1932x1910, color fundus image.
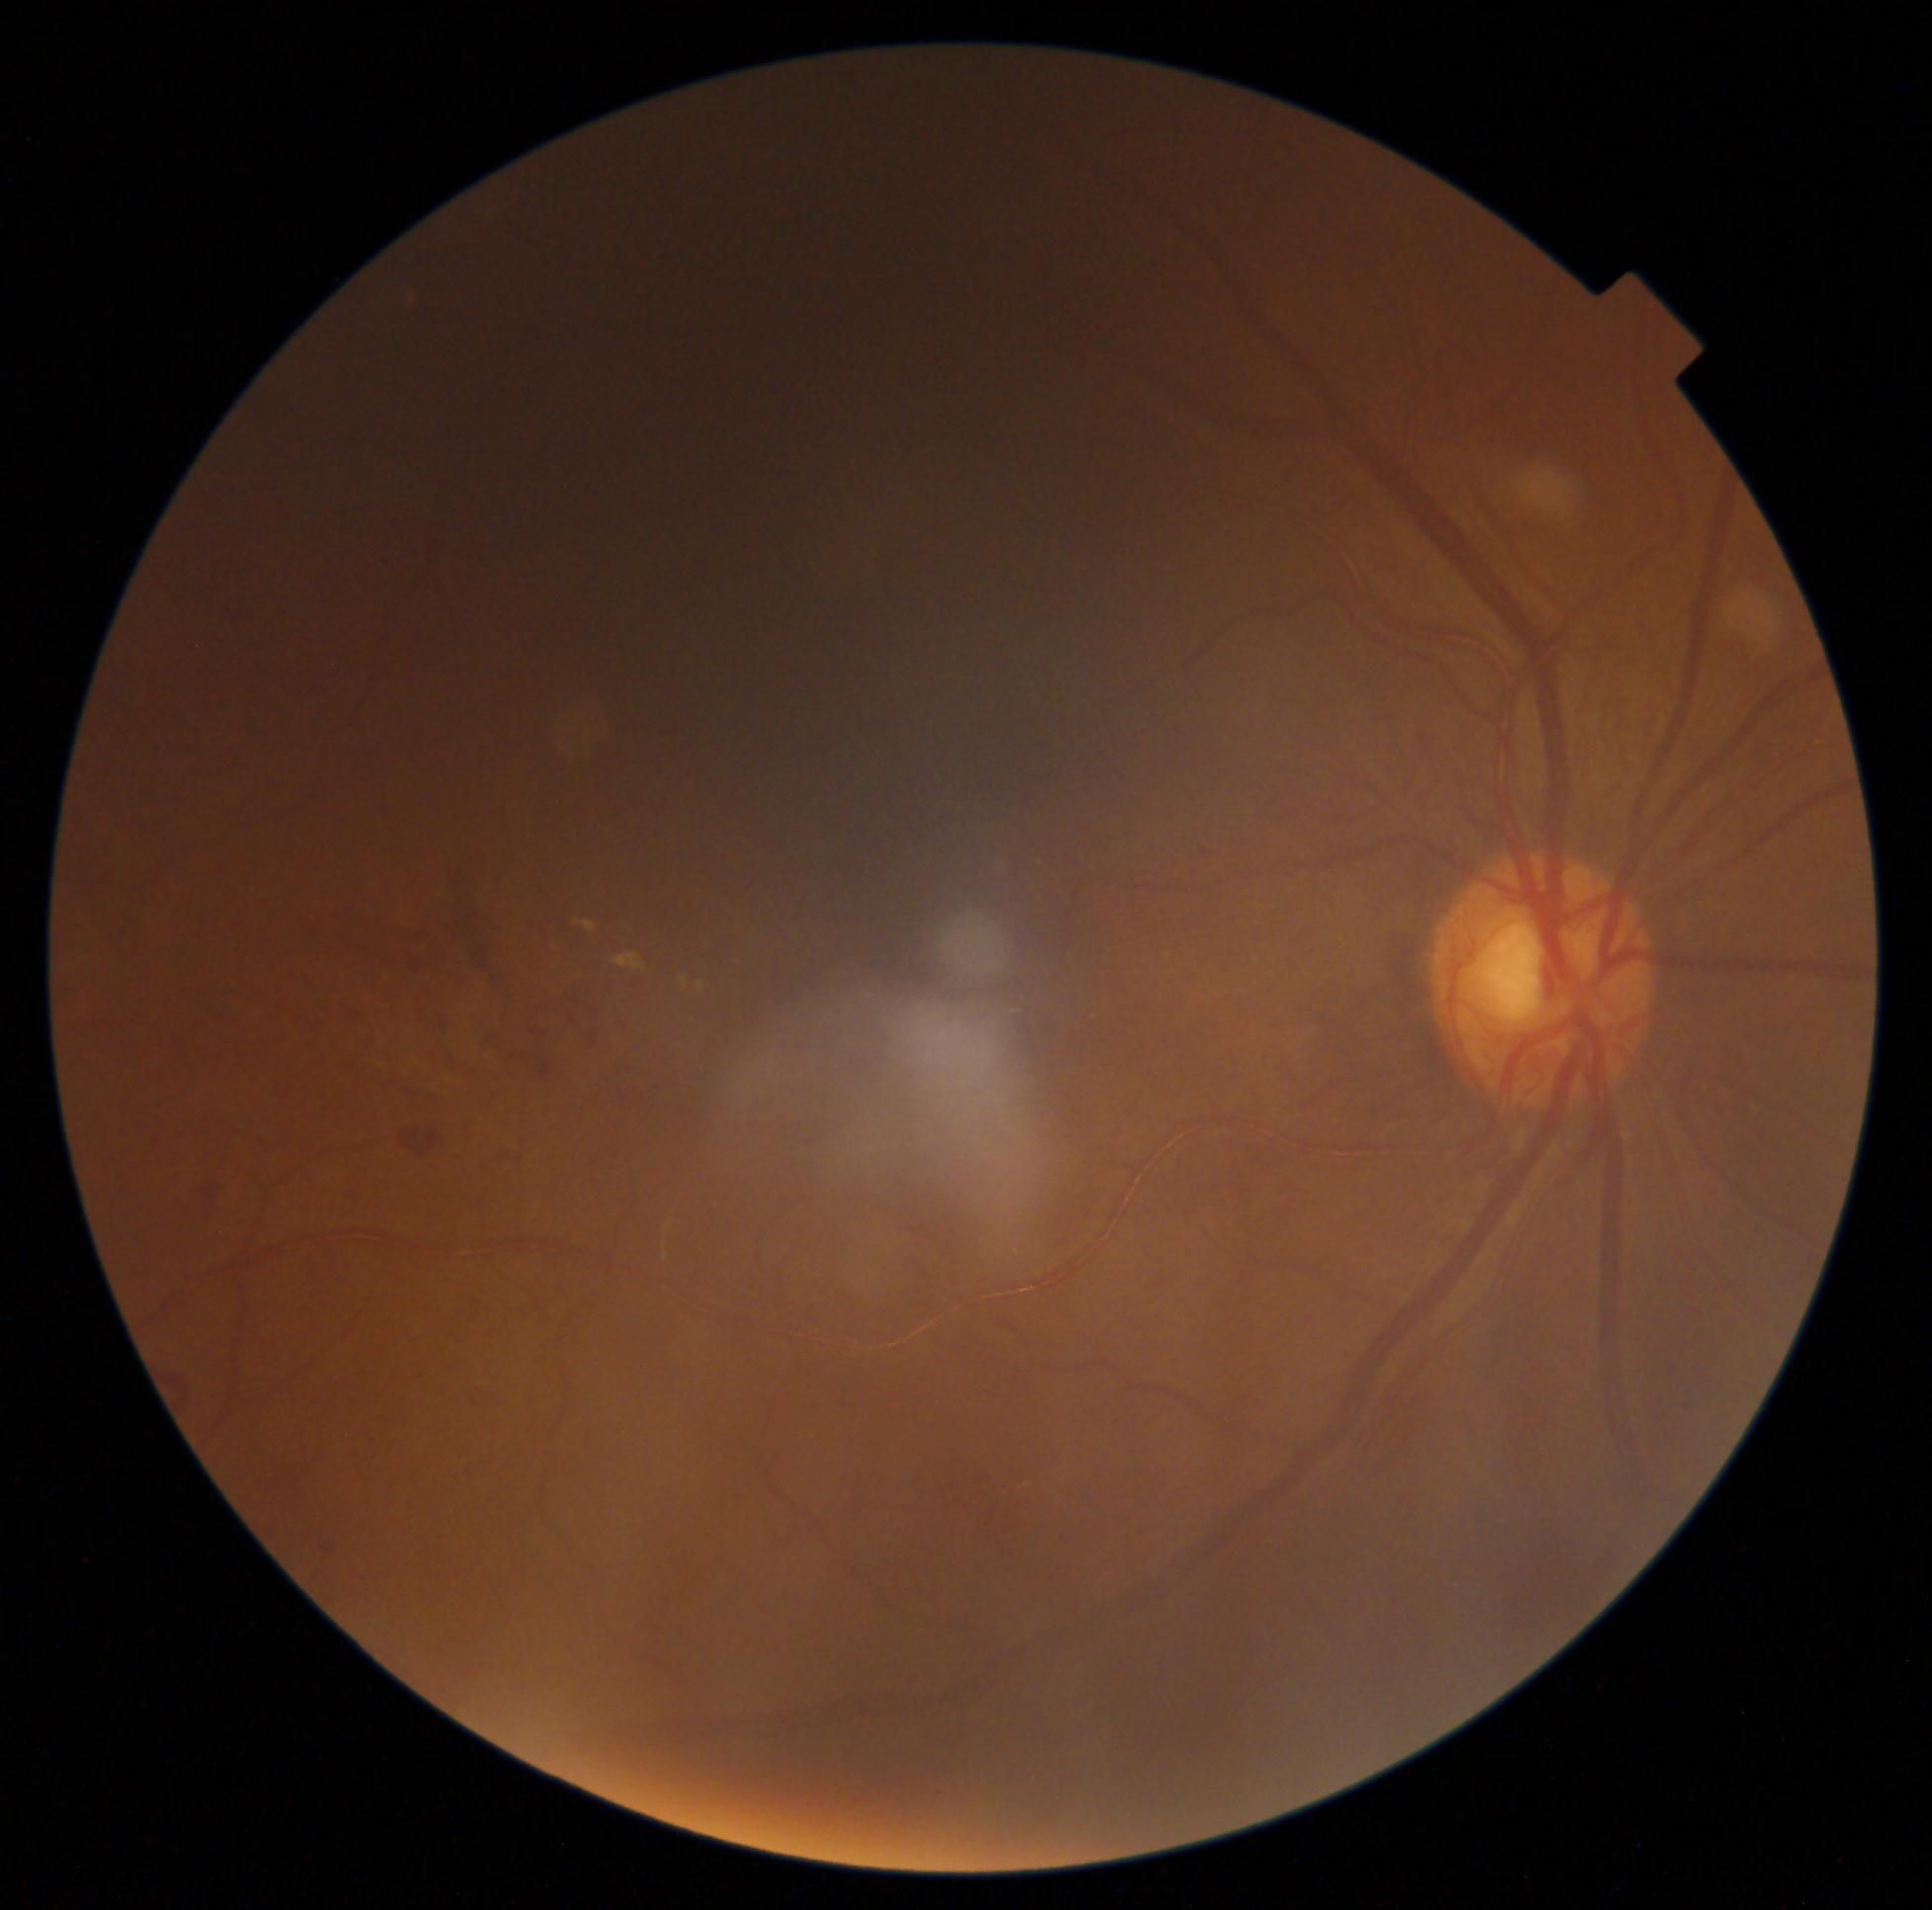 diabetic retinopathy (DR) = grade 2 (moderate NPDR).